Without pupil dilation
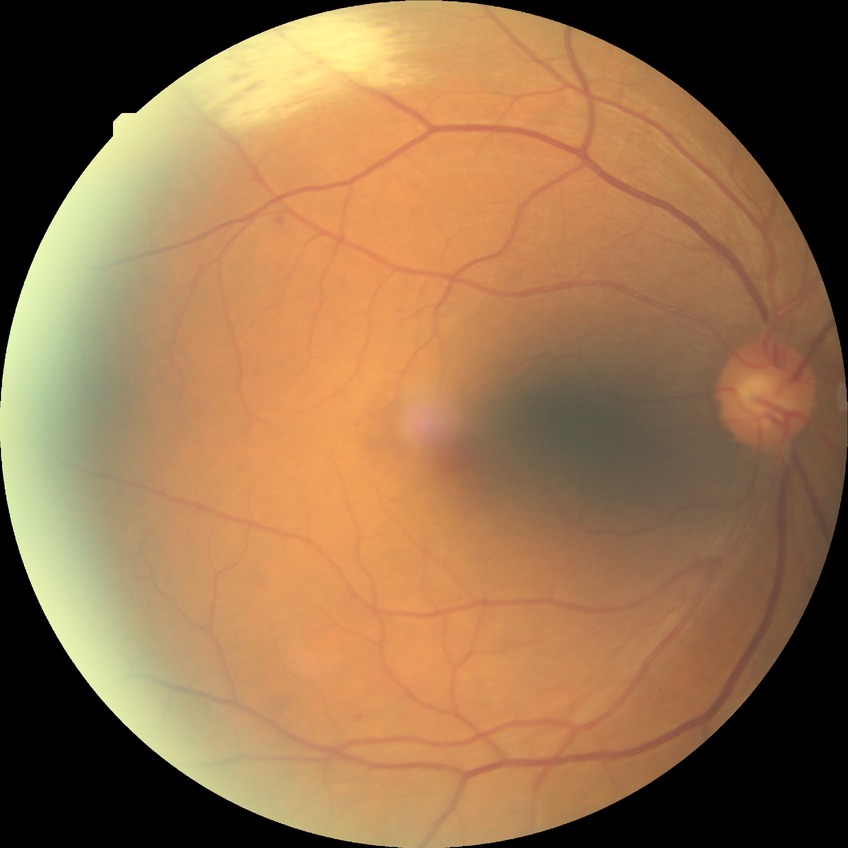 Retinopathy stage: simple diabetic retinopathy.